1932x1916
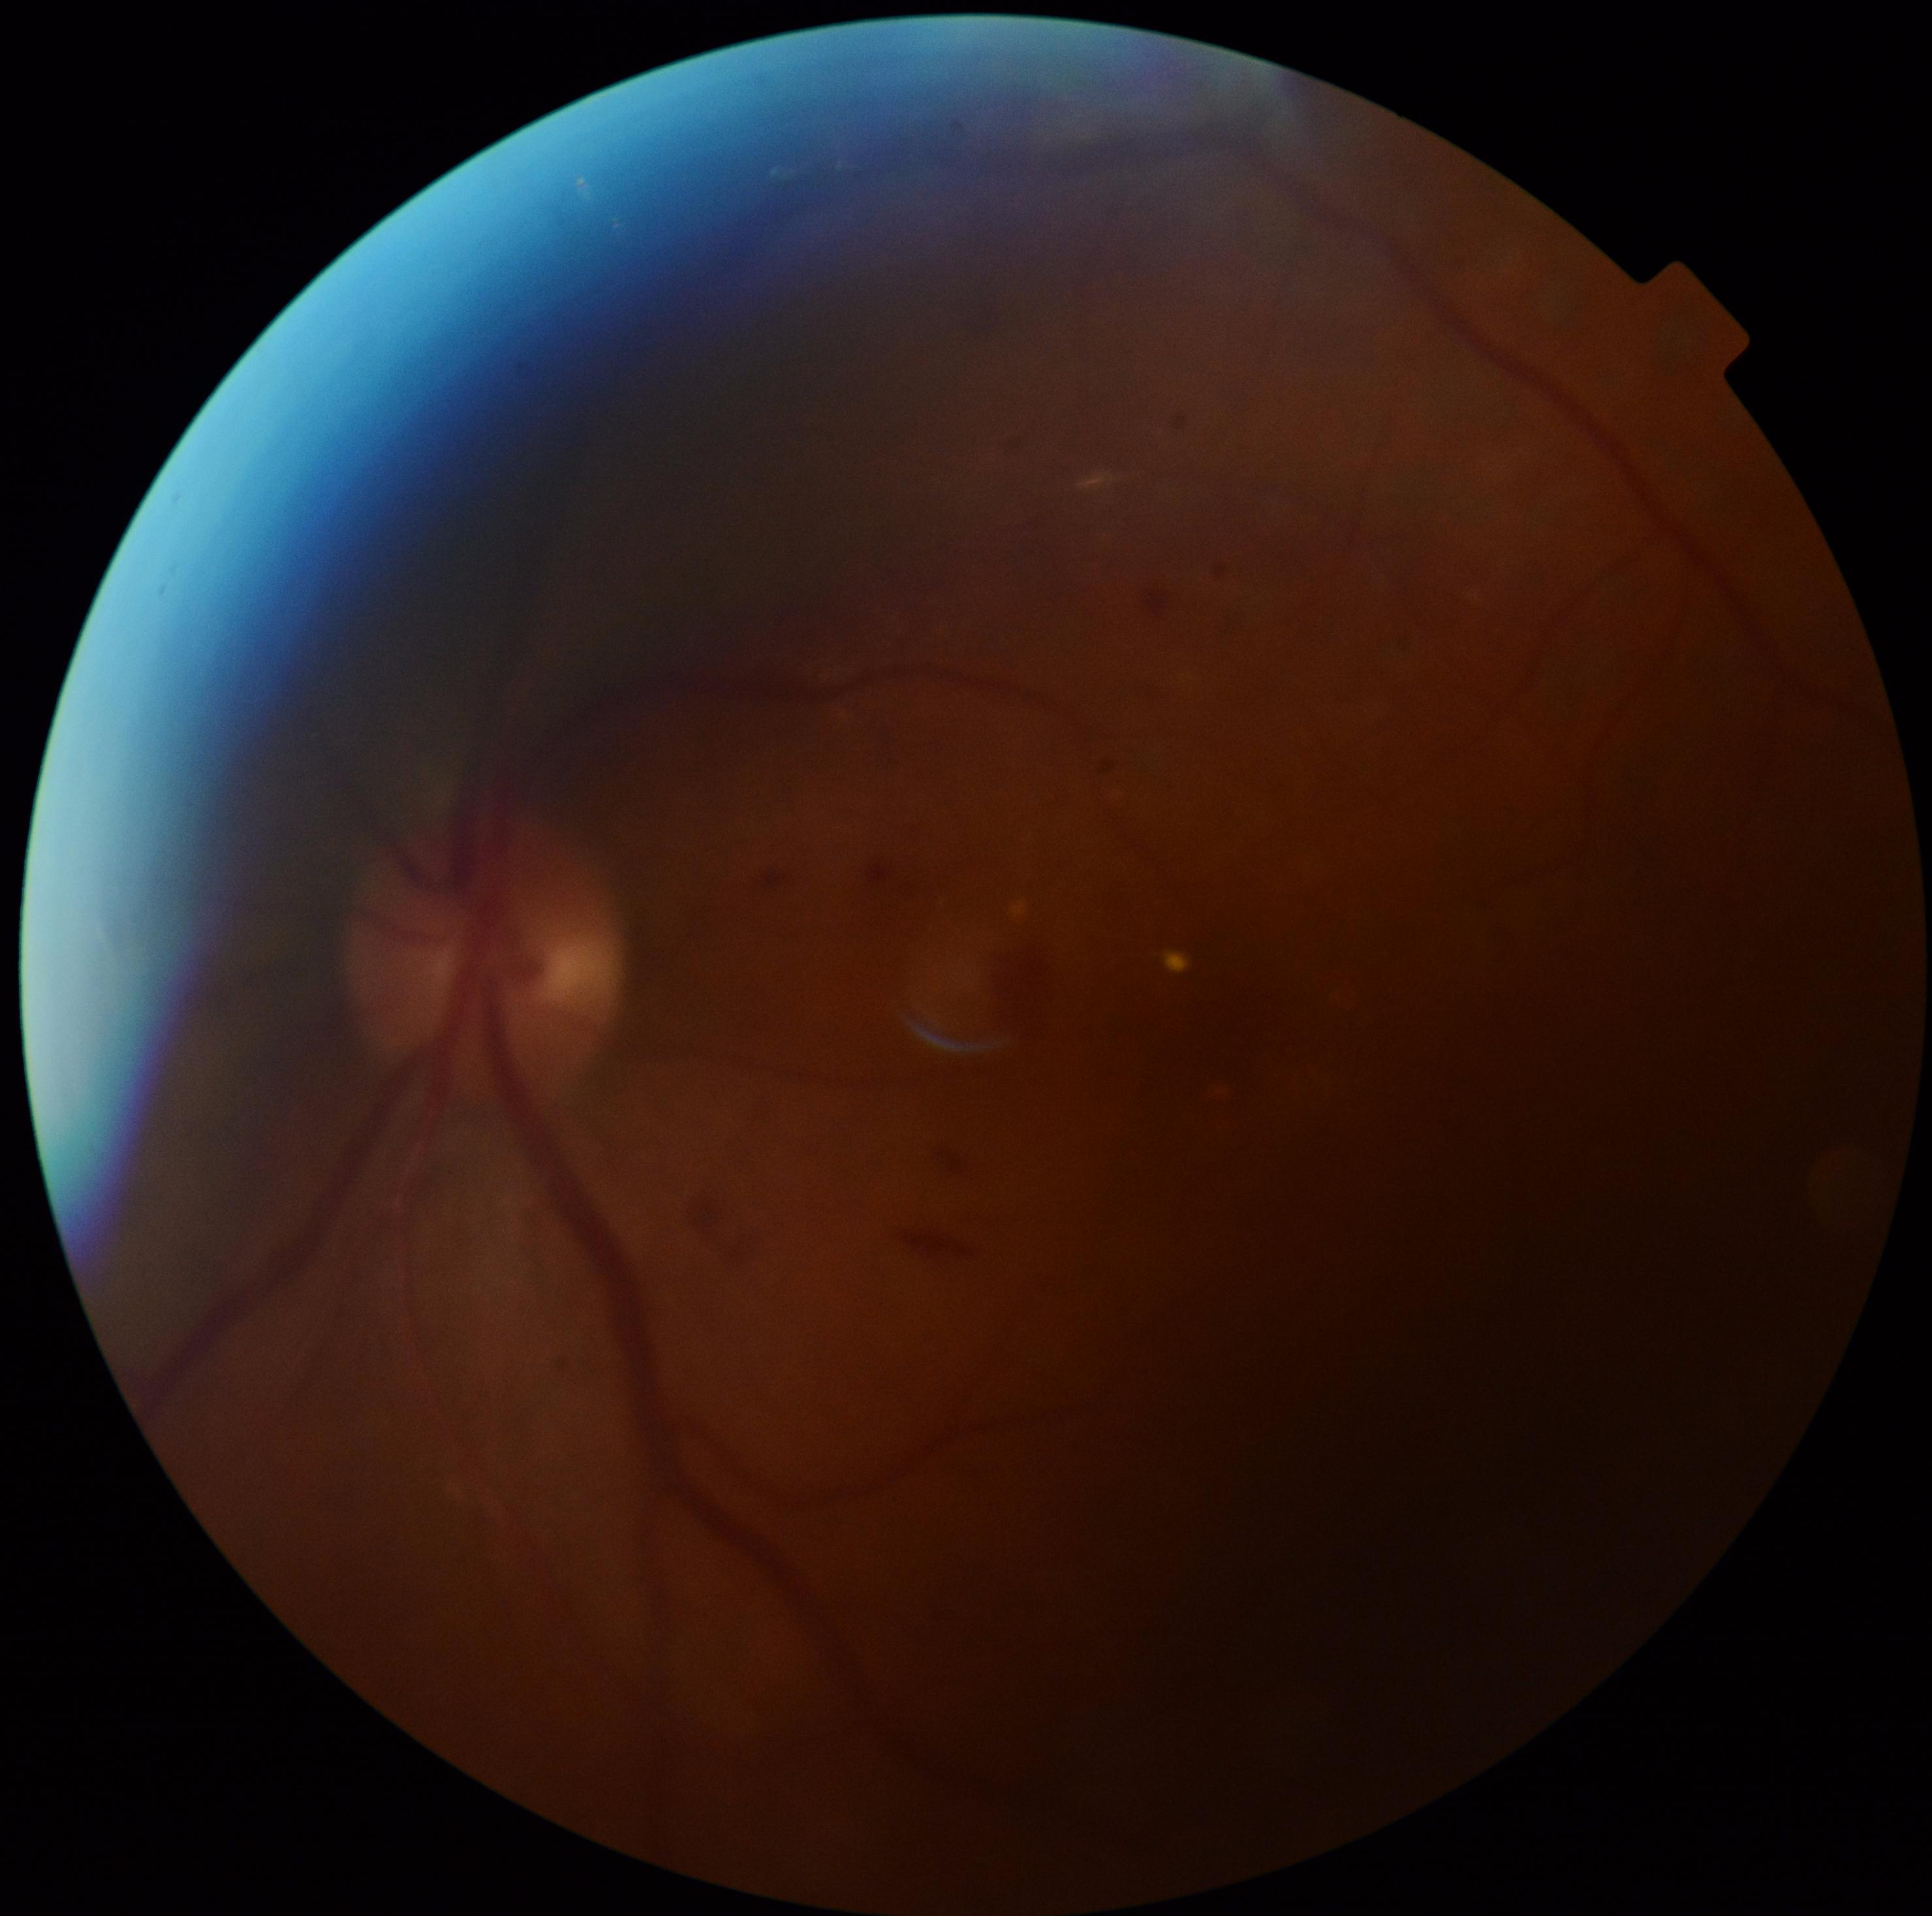 Diabetic retinopathy (DR) is moderate NPDR (grade 2).
Disease class: non-proliferative diabetic retinopathy.